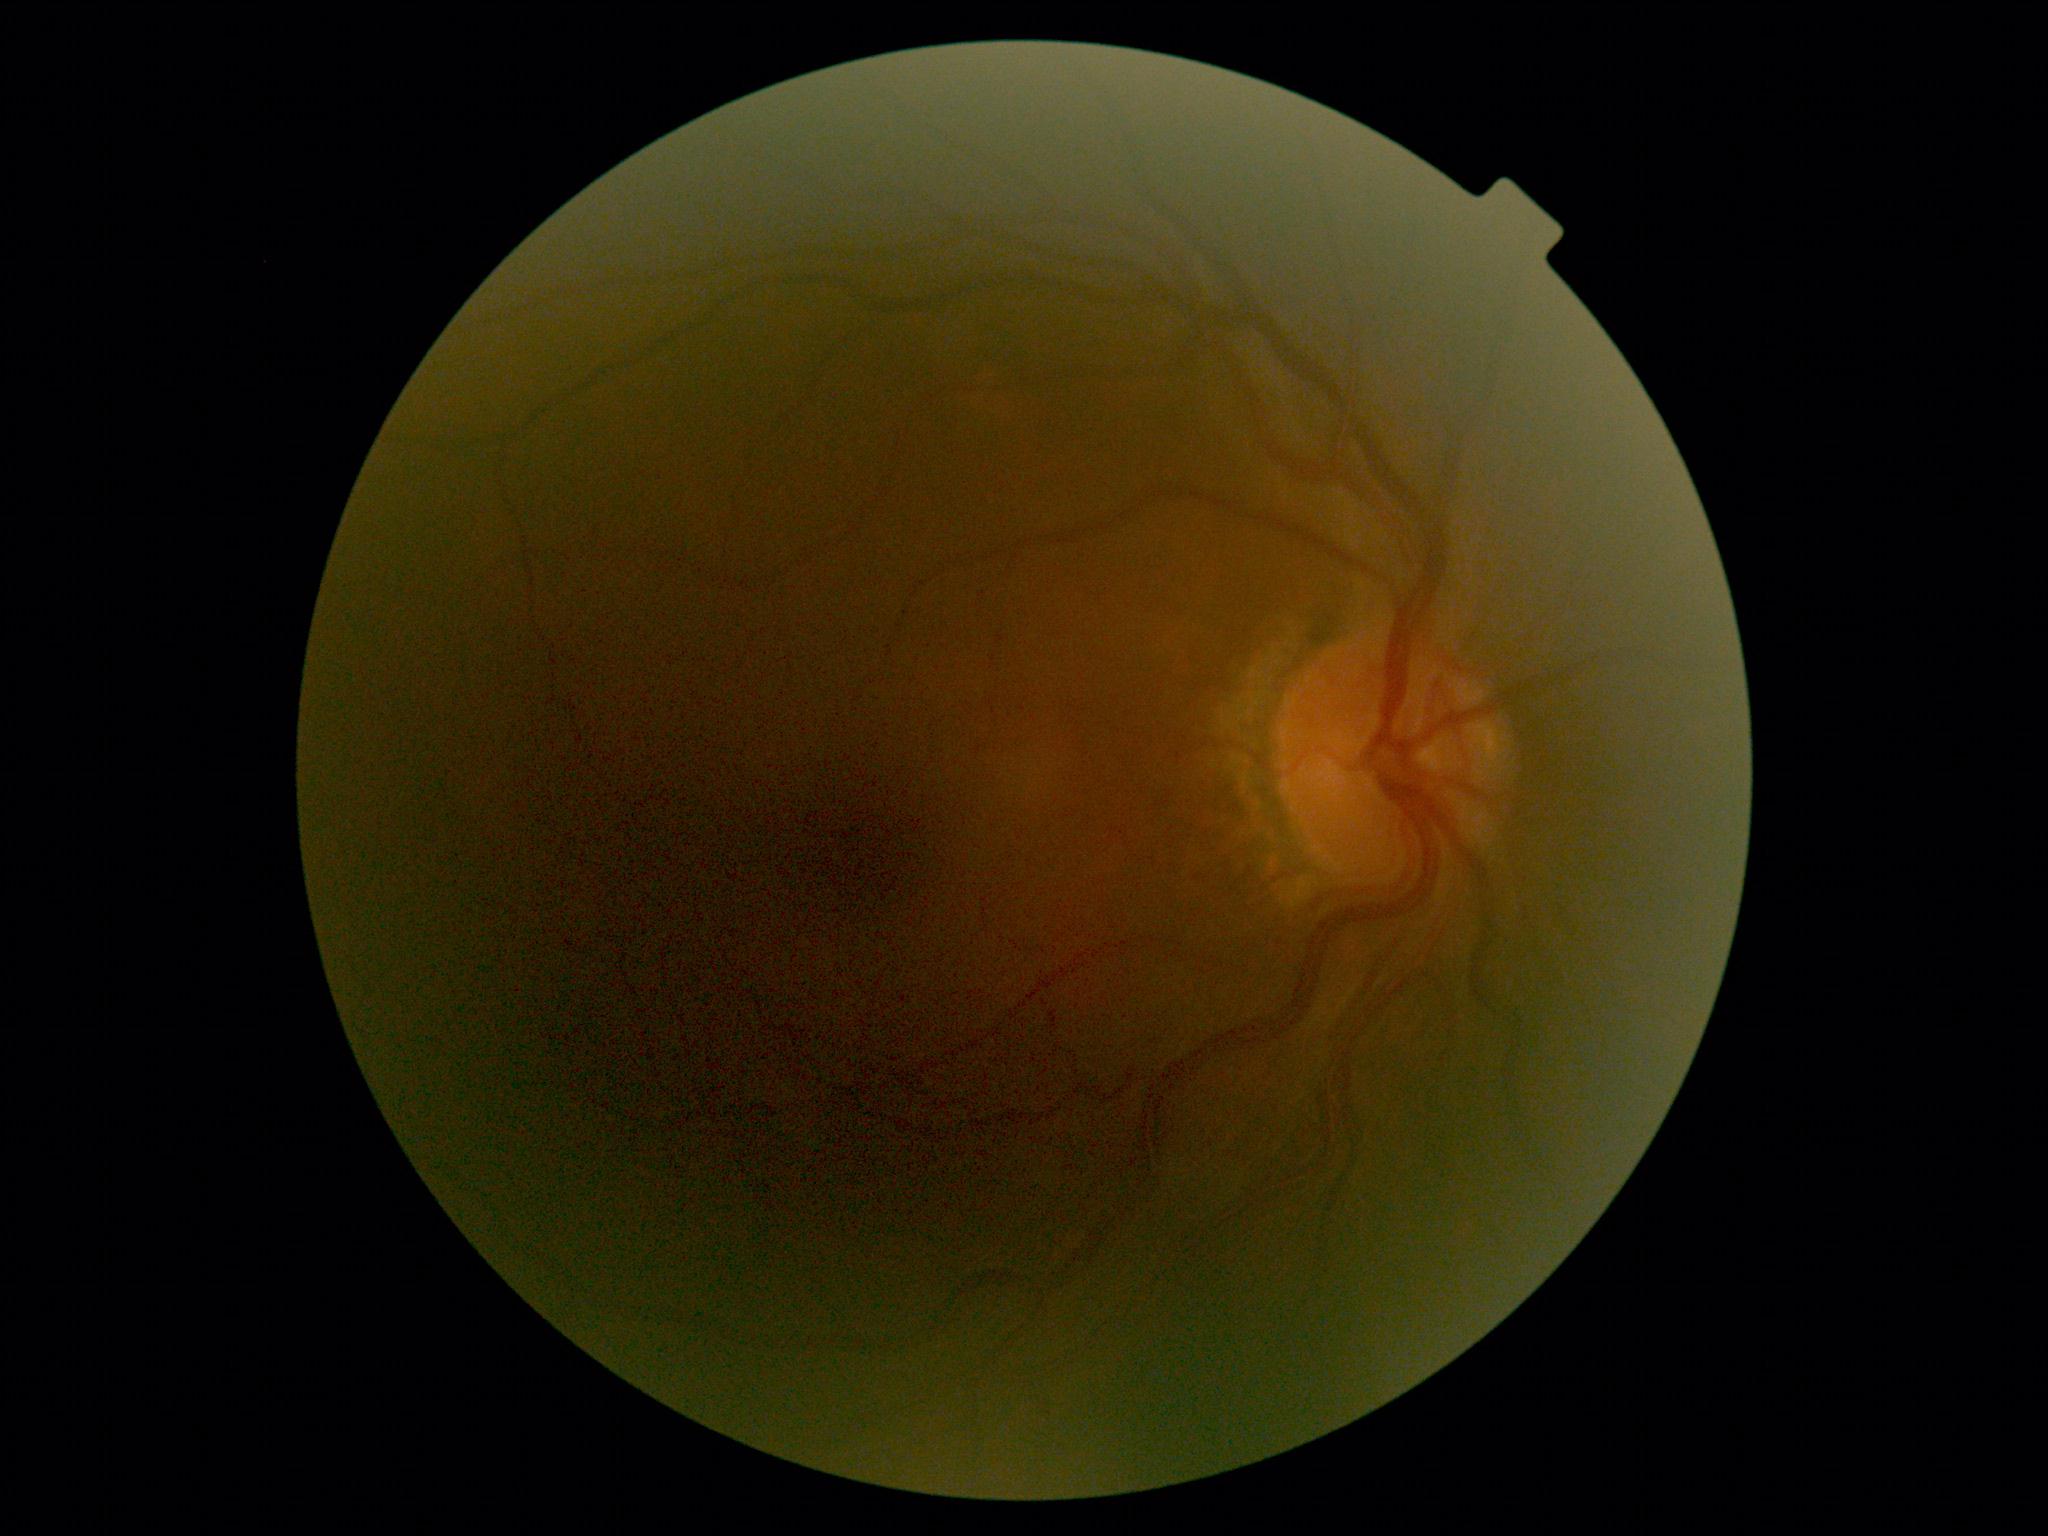

Annotations:
• DR impression: no DR findings
• diabetic retinopathy severity: grade 0 — no visible signs of diabetic retinopathy